Pediatric retinal photograph (wide-field)
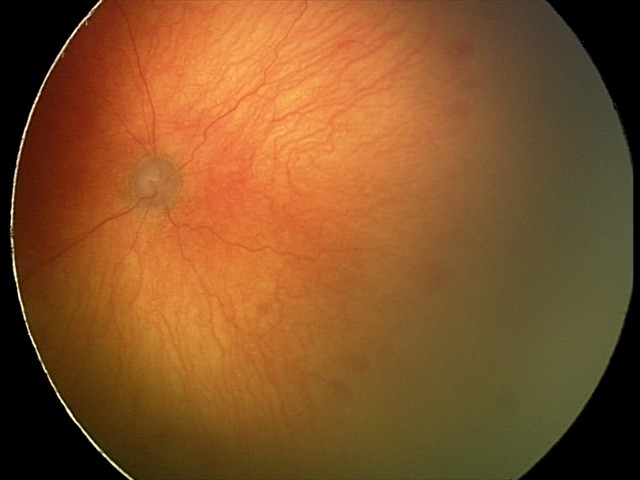 Finding: aggressive retinopathy of prematurity; plus form: present.